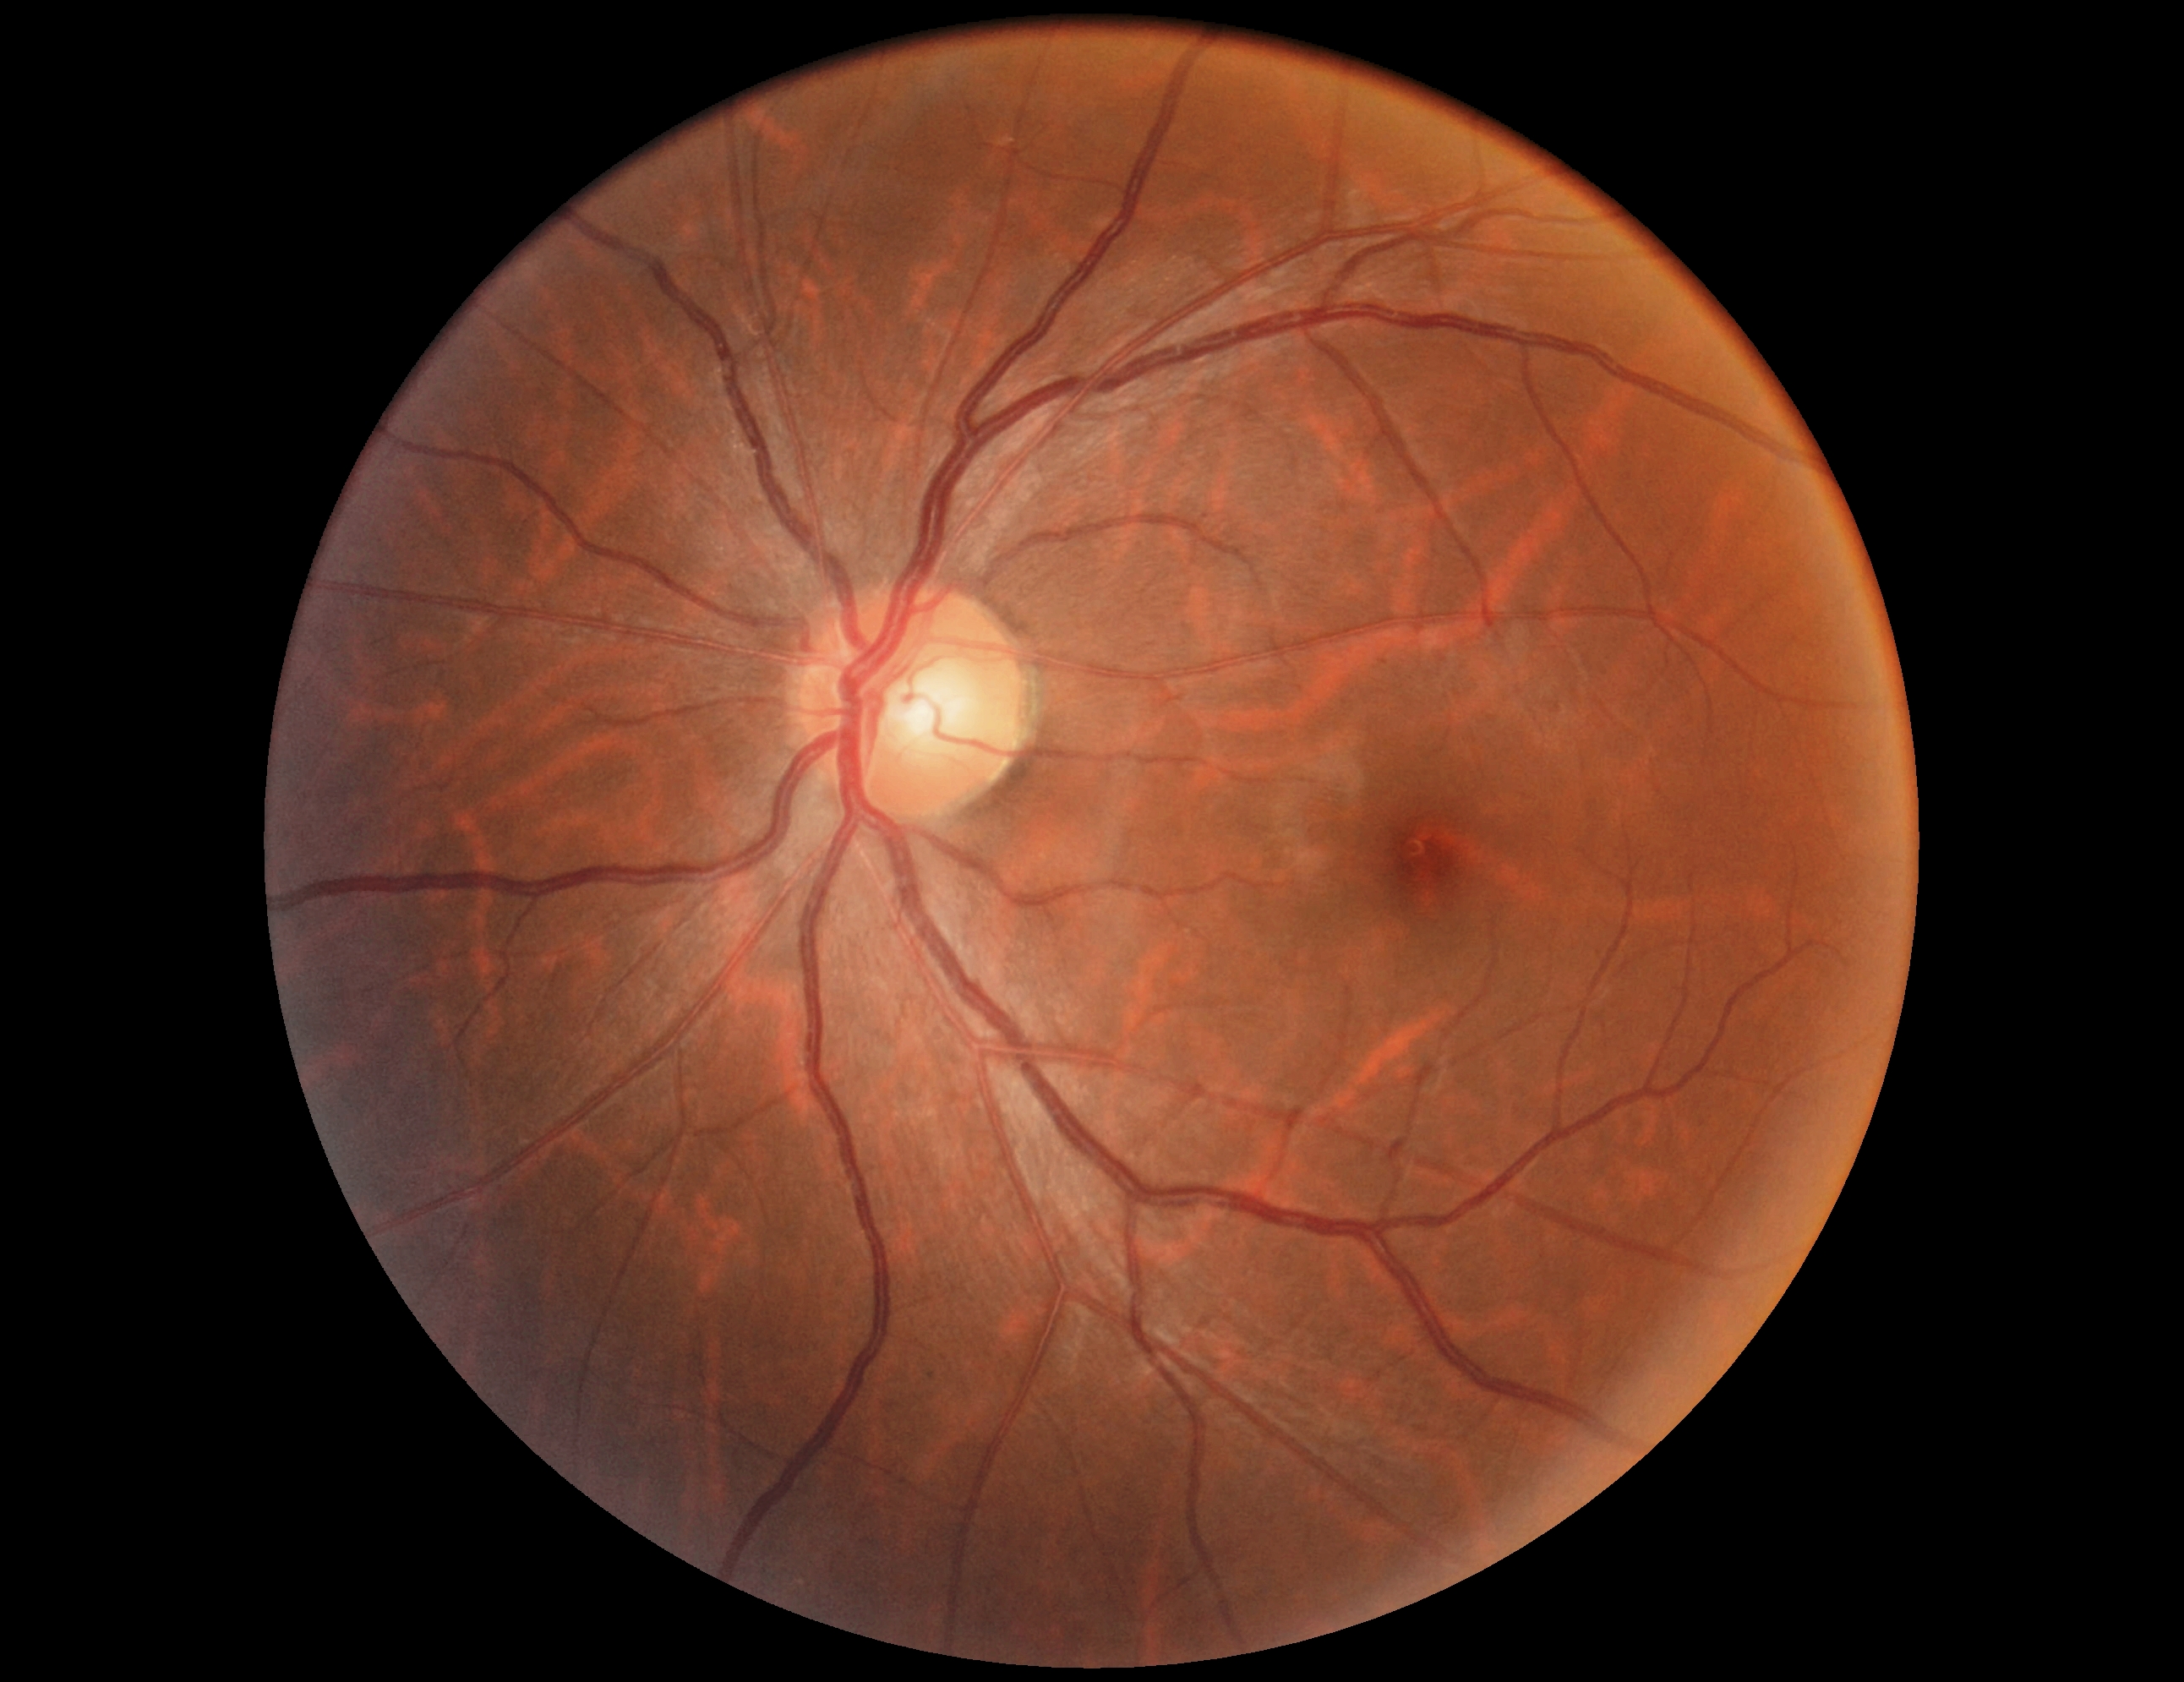
• DR impression — no apparent DR
• DR grade — 0 — no visible signs of diabetic retinopathy